Wide-field fundus photograph of an infant. Captured with the Clarity RetCam 3 (130° field of view).
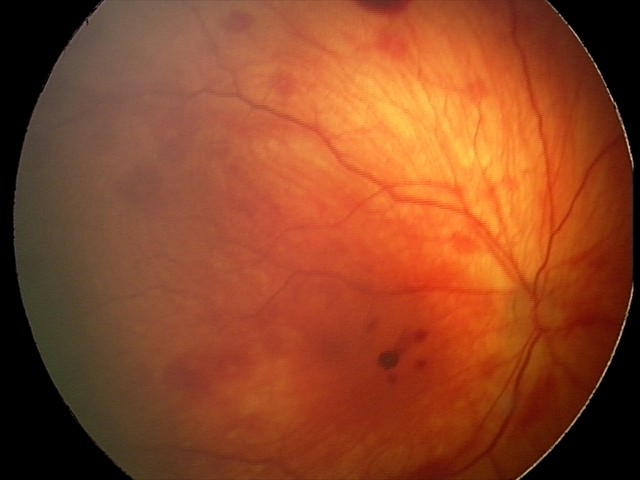
Screening examination consistent with retinal hemorrhages.